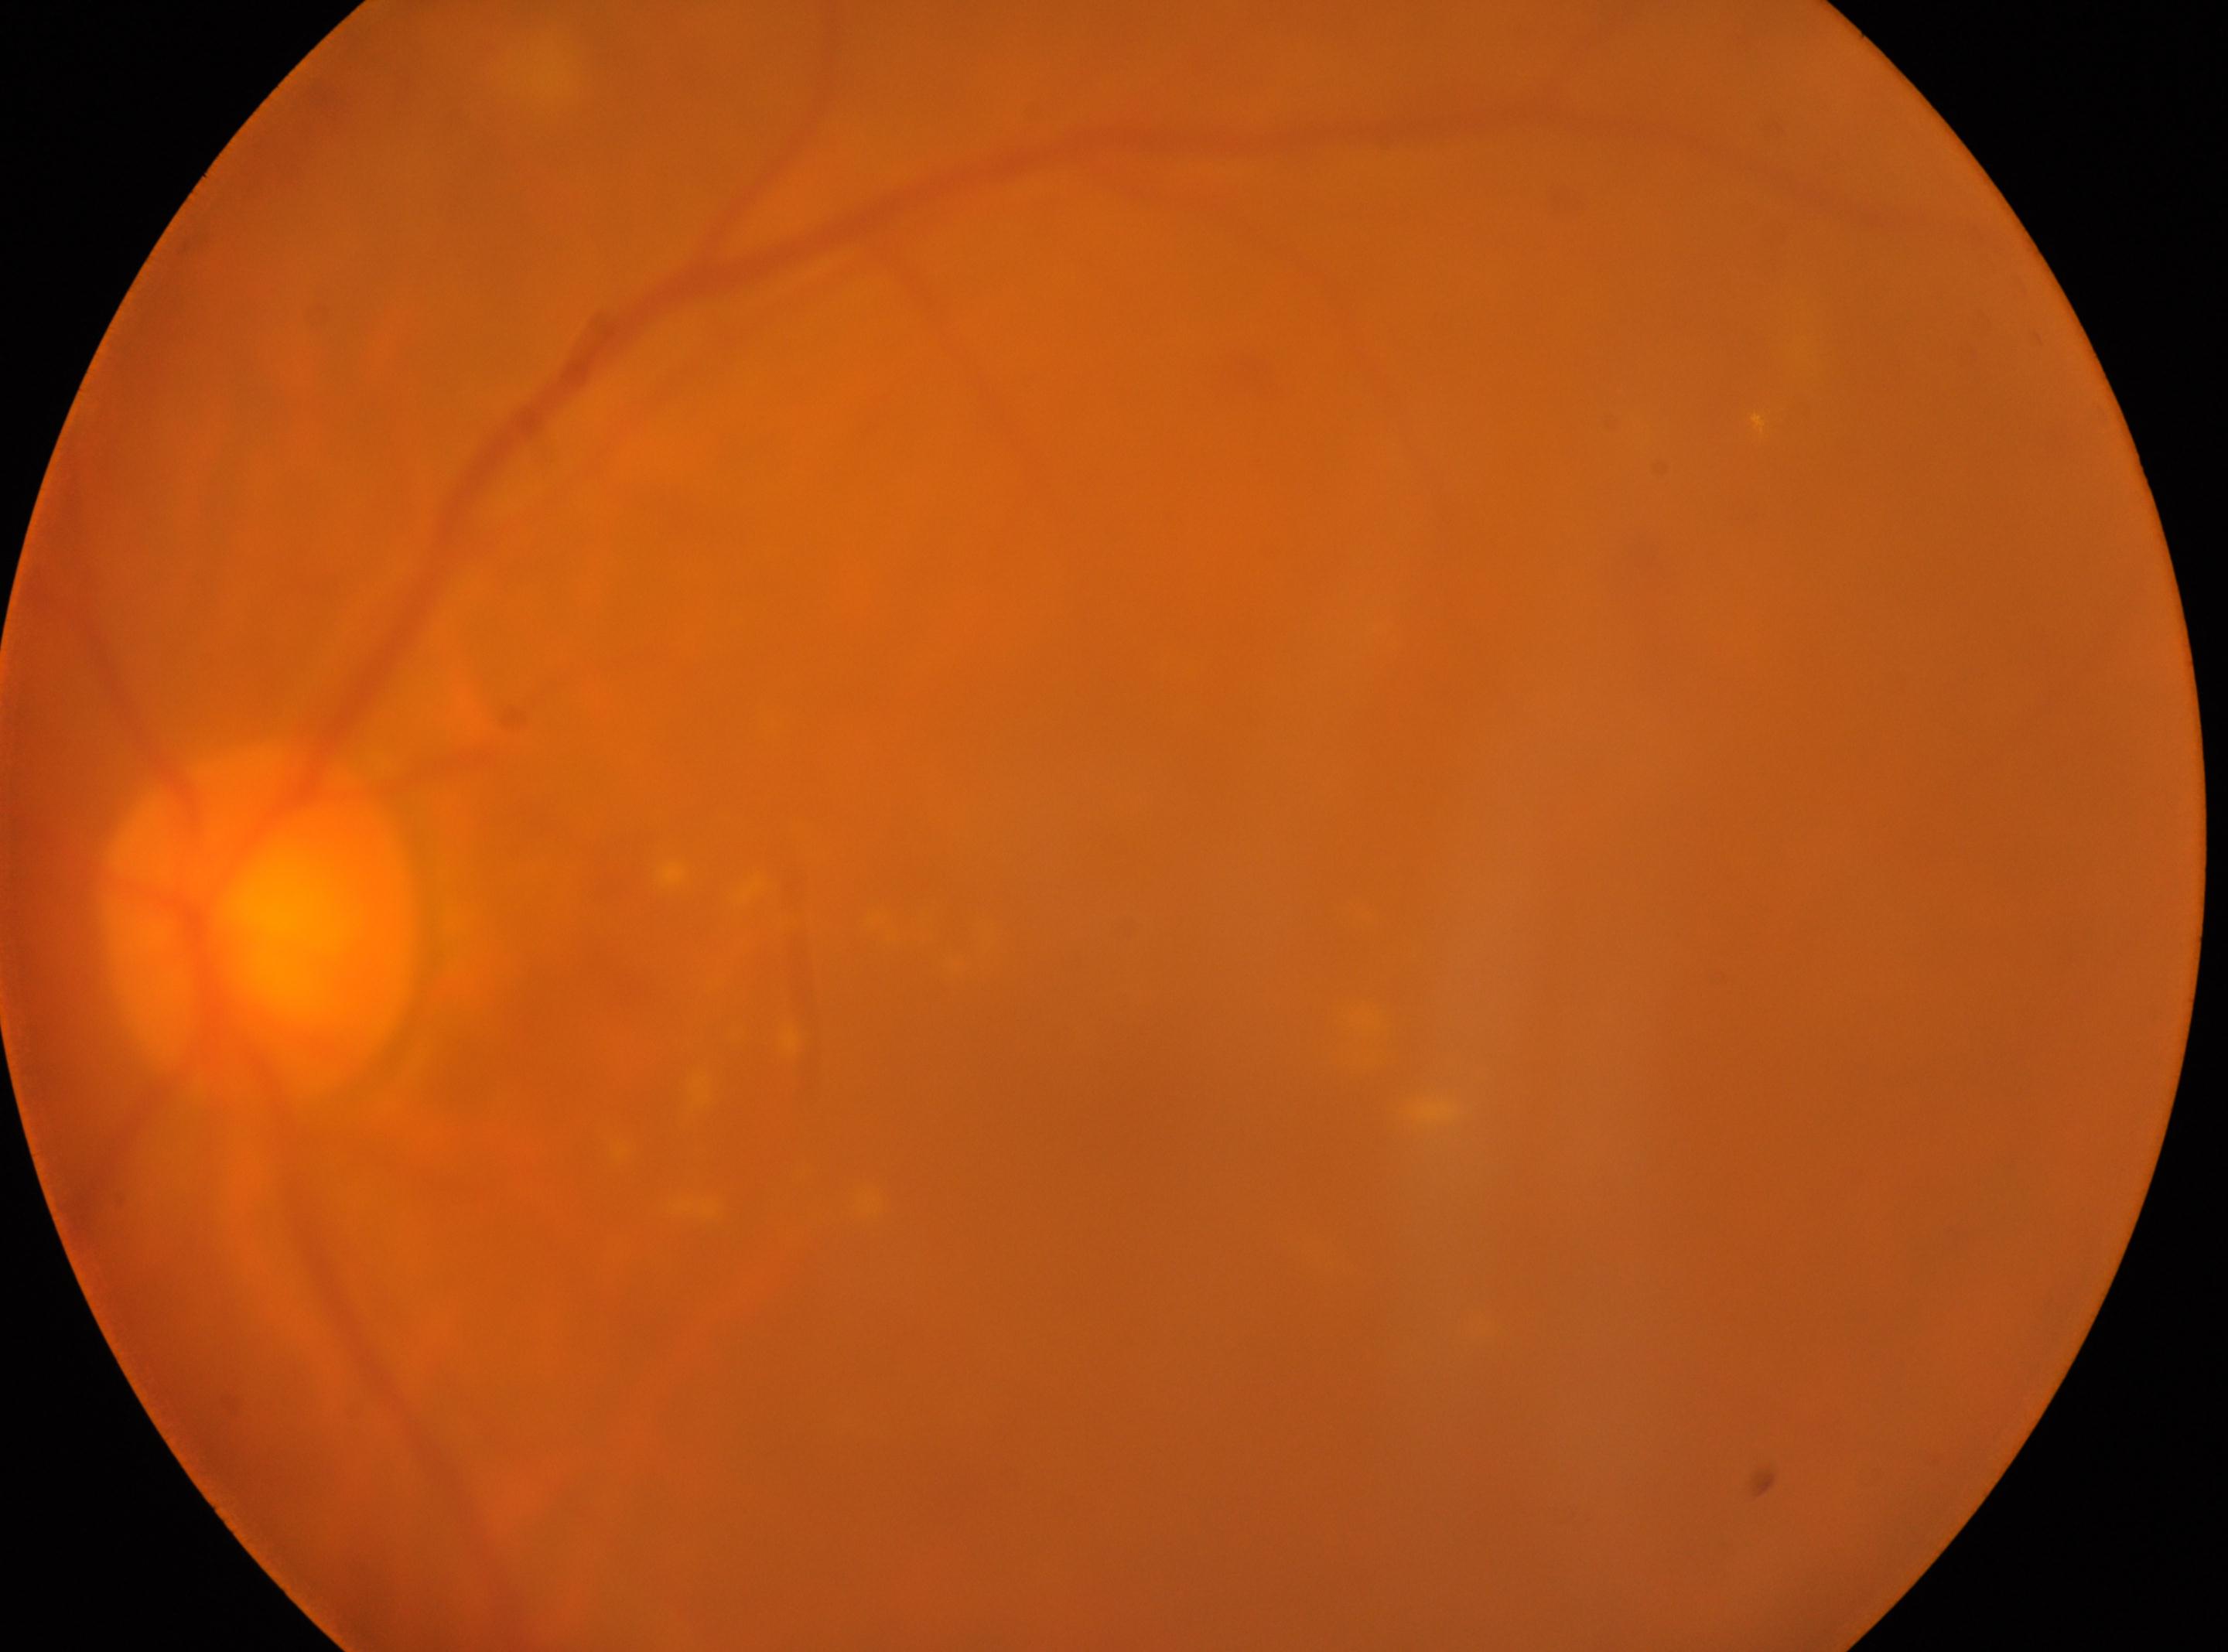

optic disc center = (x: 258, y: 923)
diabetic retinopathy = grade 2 (moderate NPDR)
eye = OS
foveal center = (x: 1142, y: 1056)
DR class = non-proliferative diabetic retinopathy